FOV: 45 degrees:
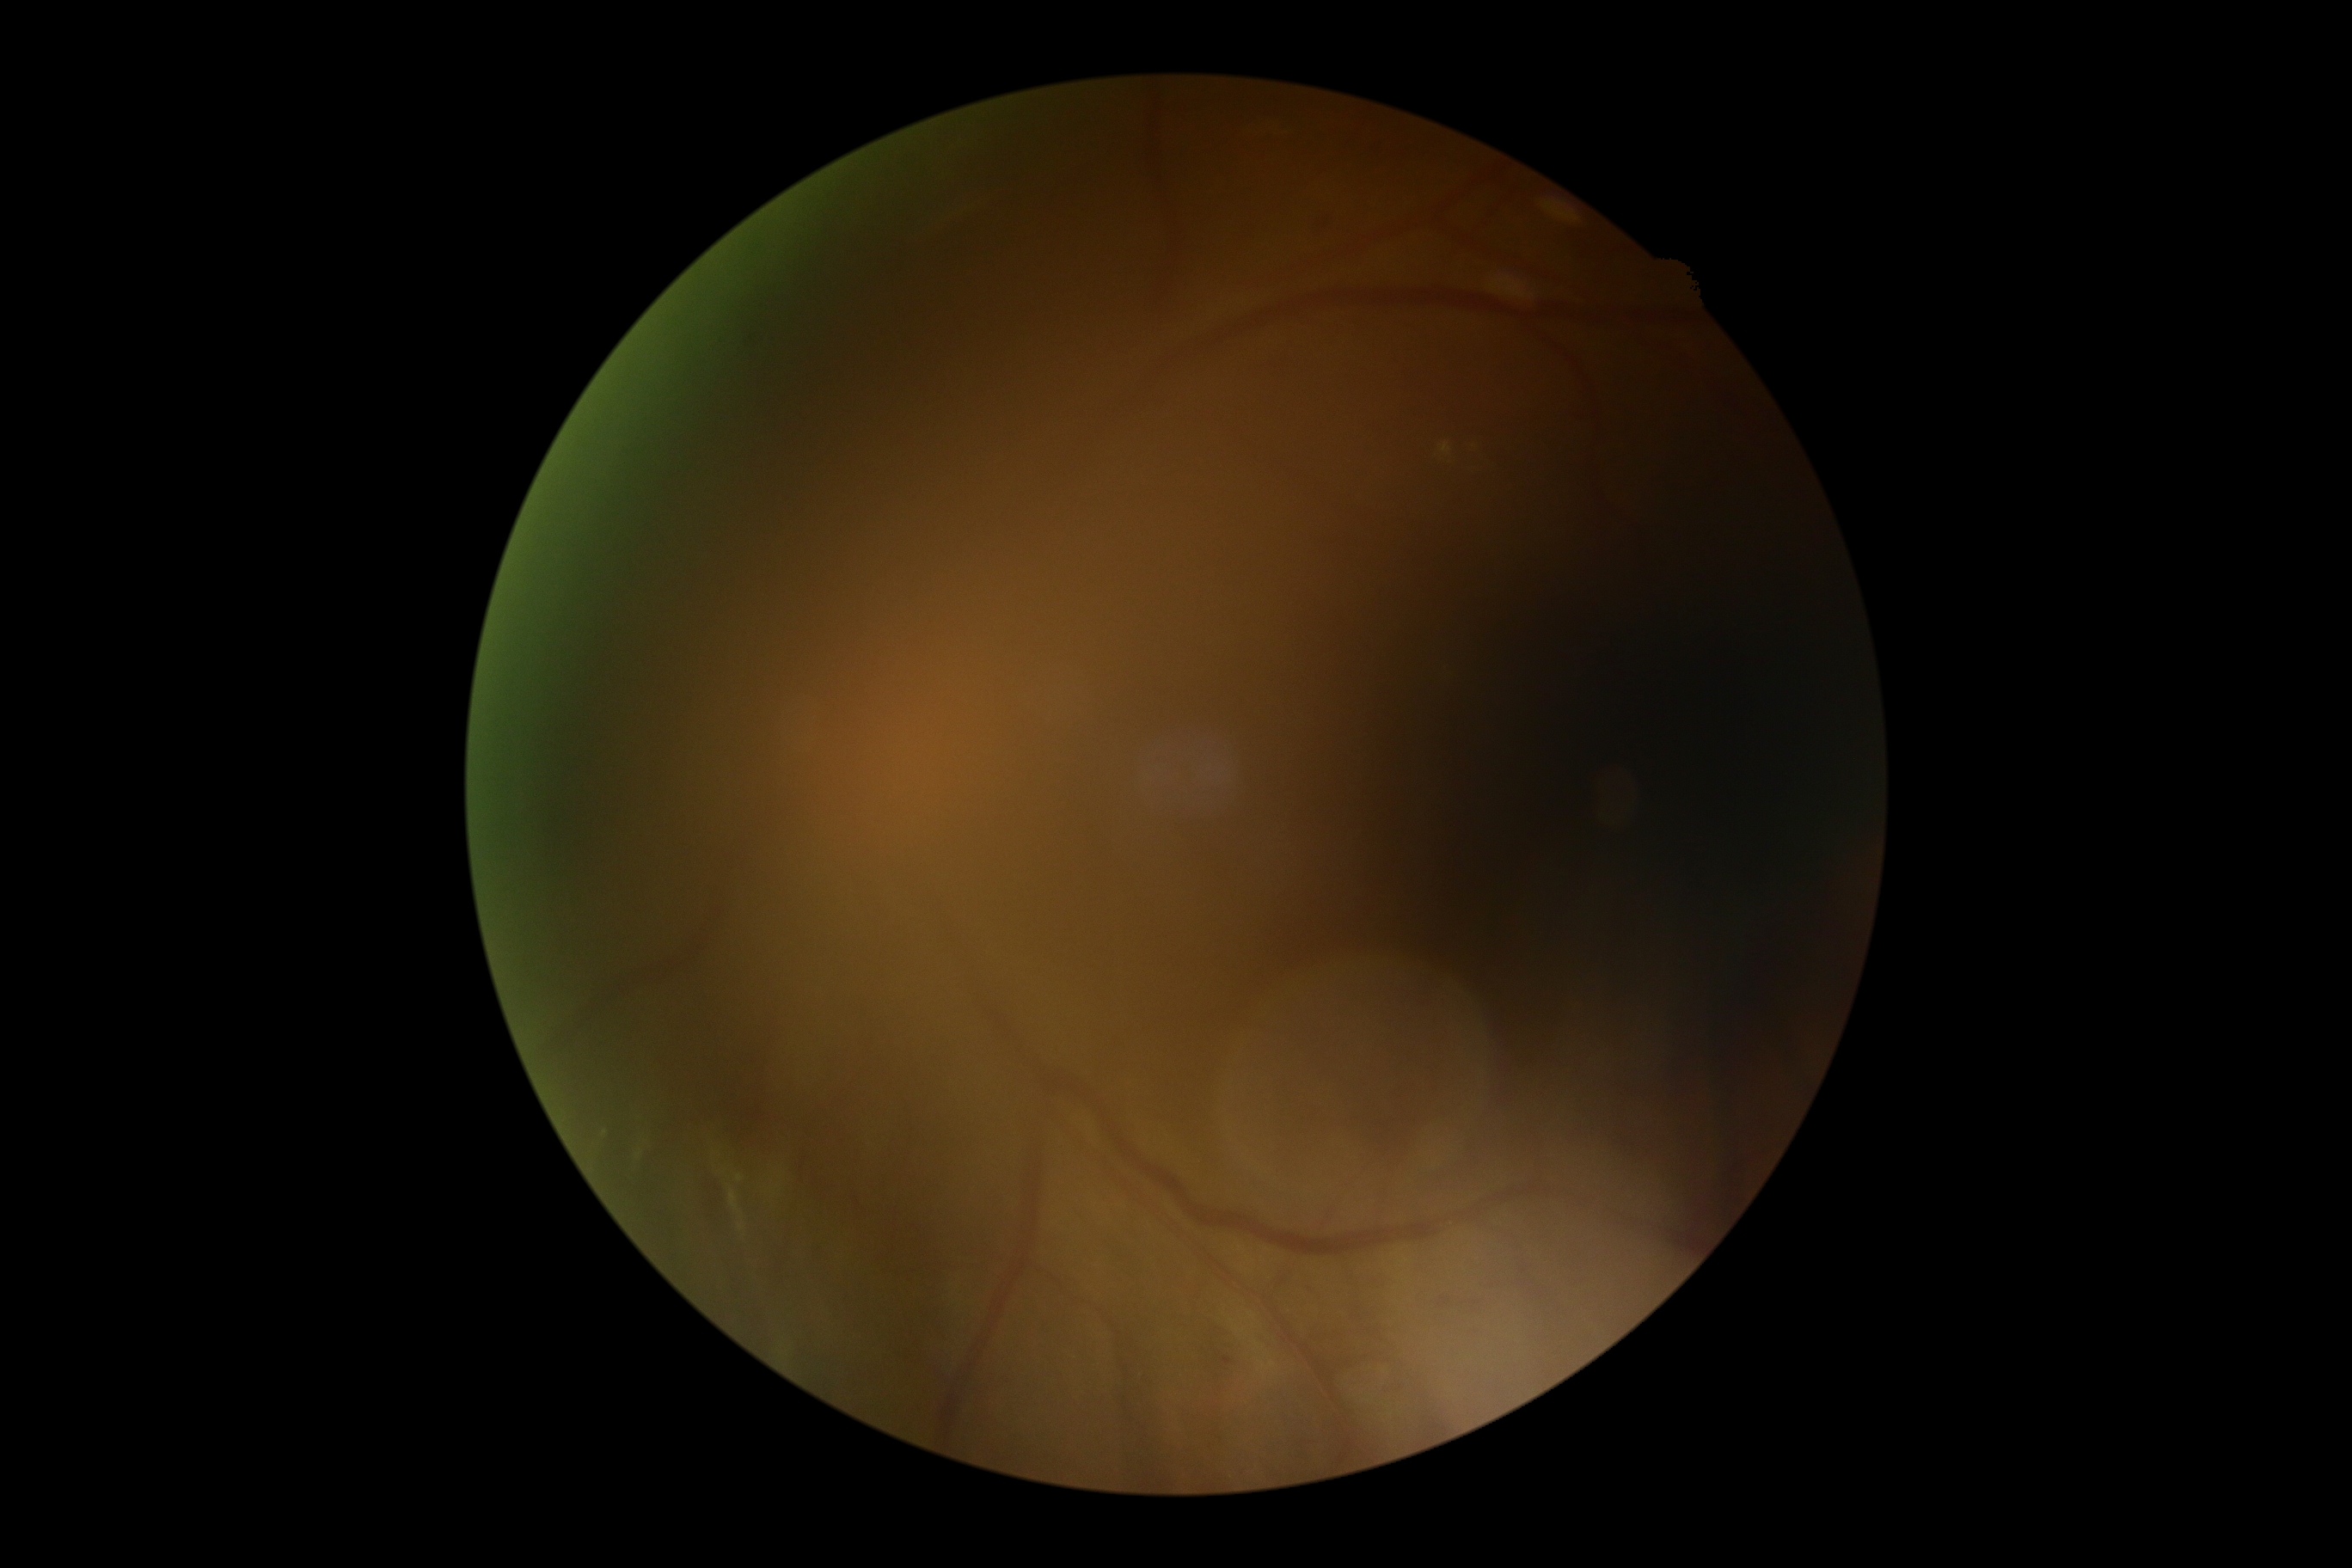

Diabetic retinopathy (DR): grade 2. Disease class: non-proliferative diabetic retinopathy.